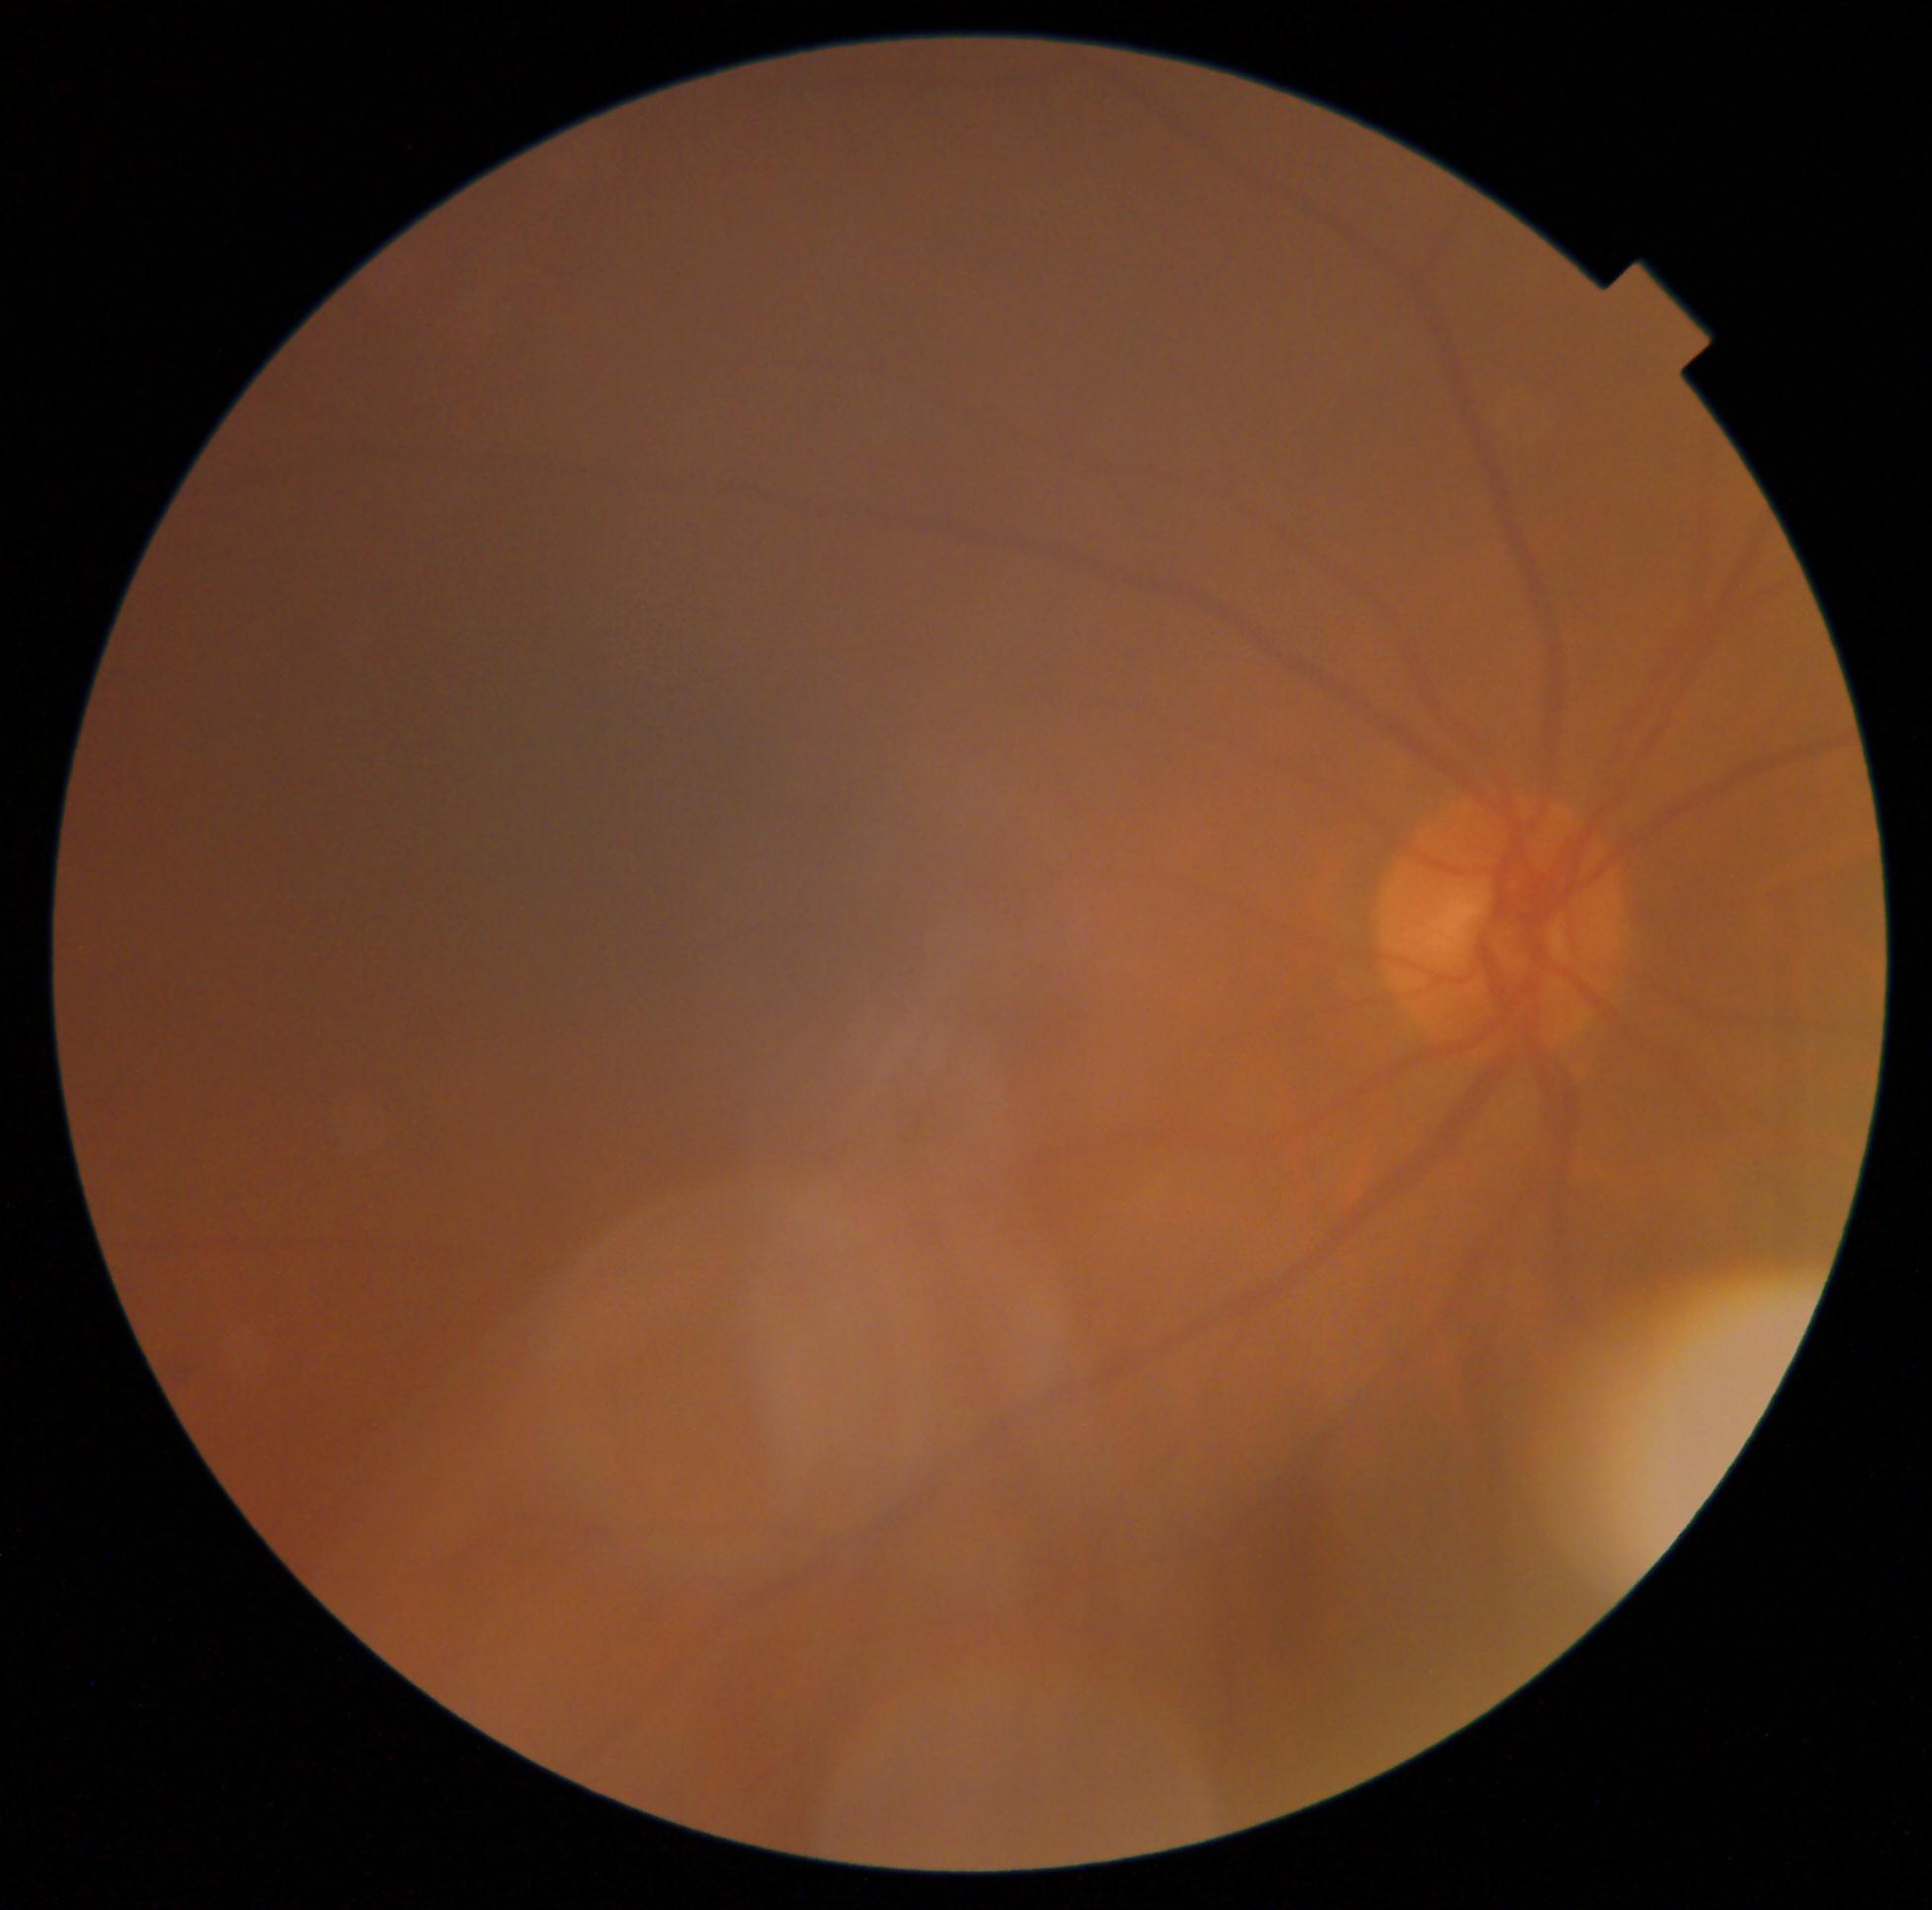

DR impression@no DR findings, DR@no apparent diabetic retinopathy (grade 0).